45 degree fundus photograph, DR severity per modified Davis staging
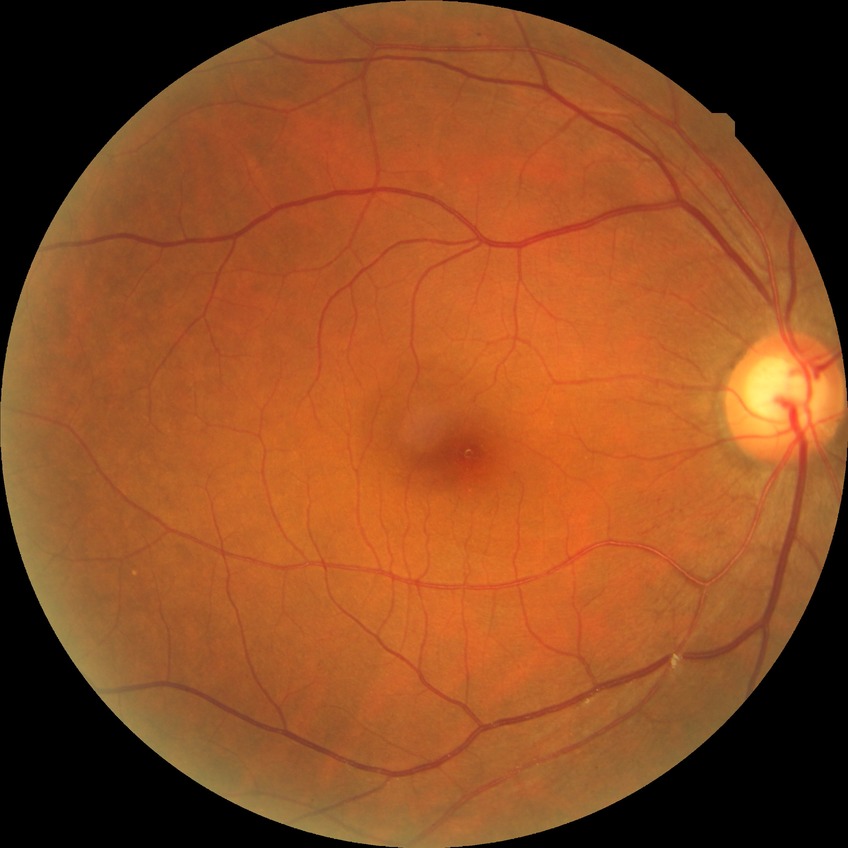
{"davis_grade": "NDR (no diabetic retinopathy)"}